Retinal fundus photograph; nonmydriatic; NIDEK AFC-230: 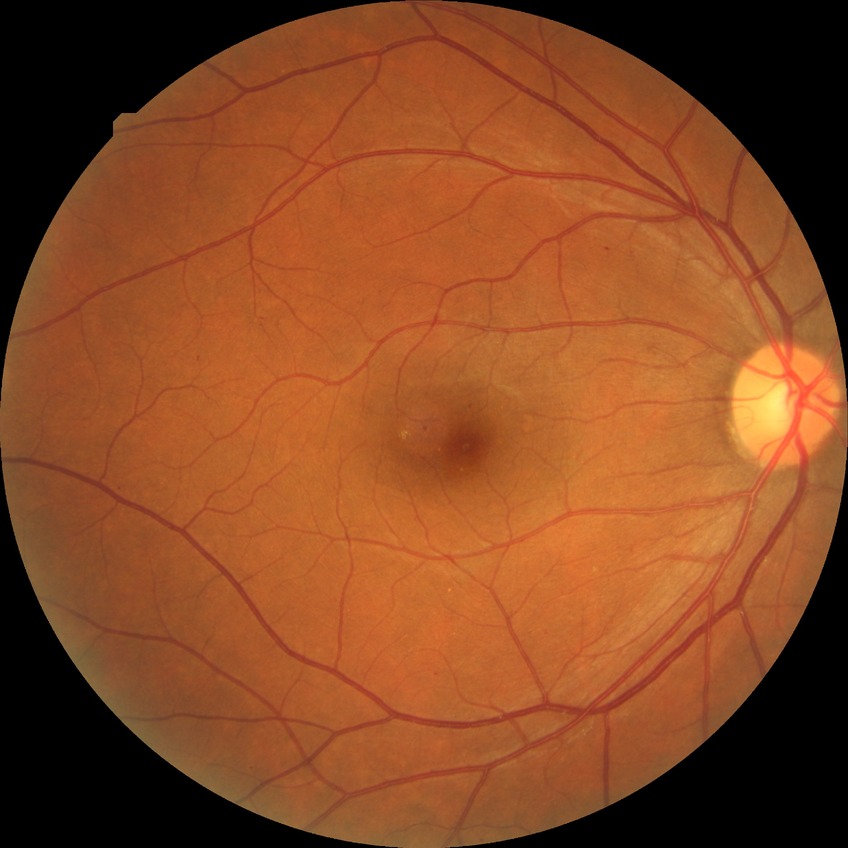
DR grade: SDR.